200-degree field of view. UWF retinal mosaic:
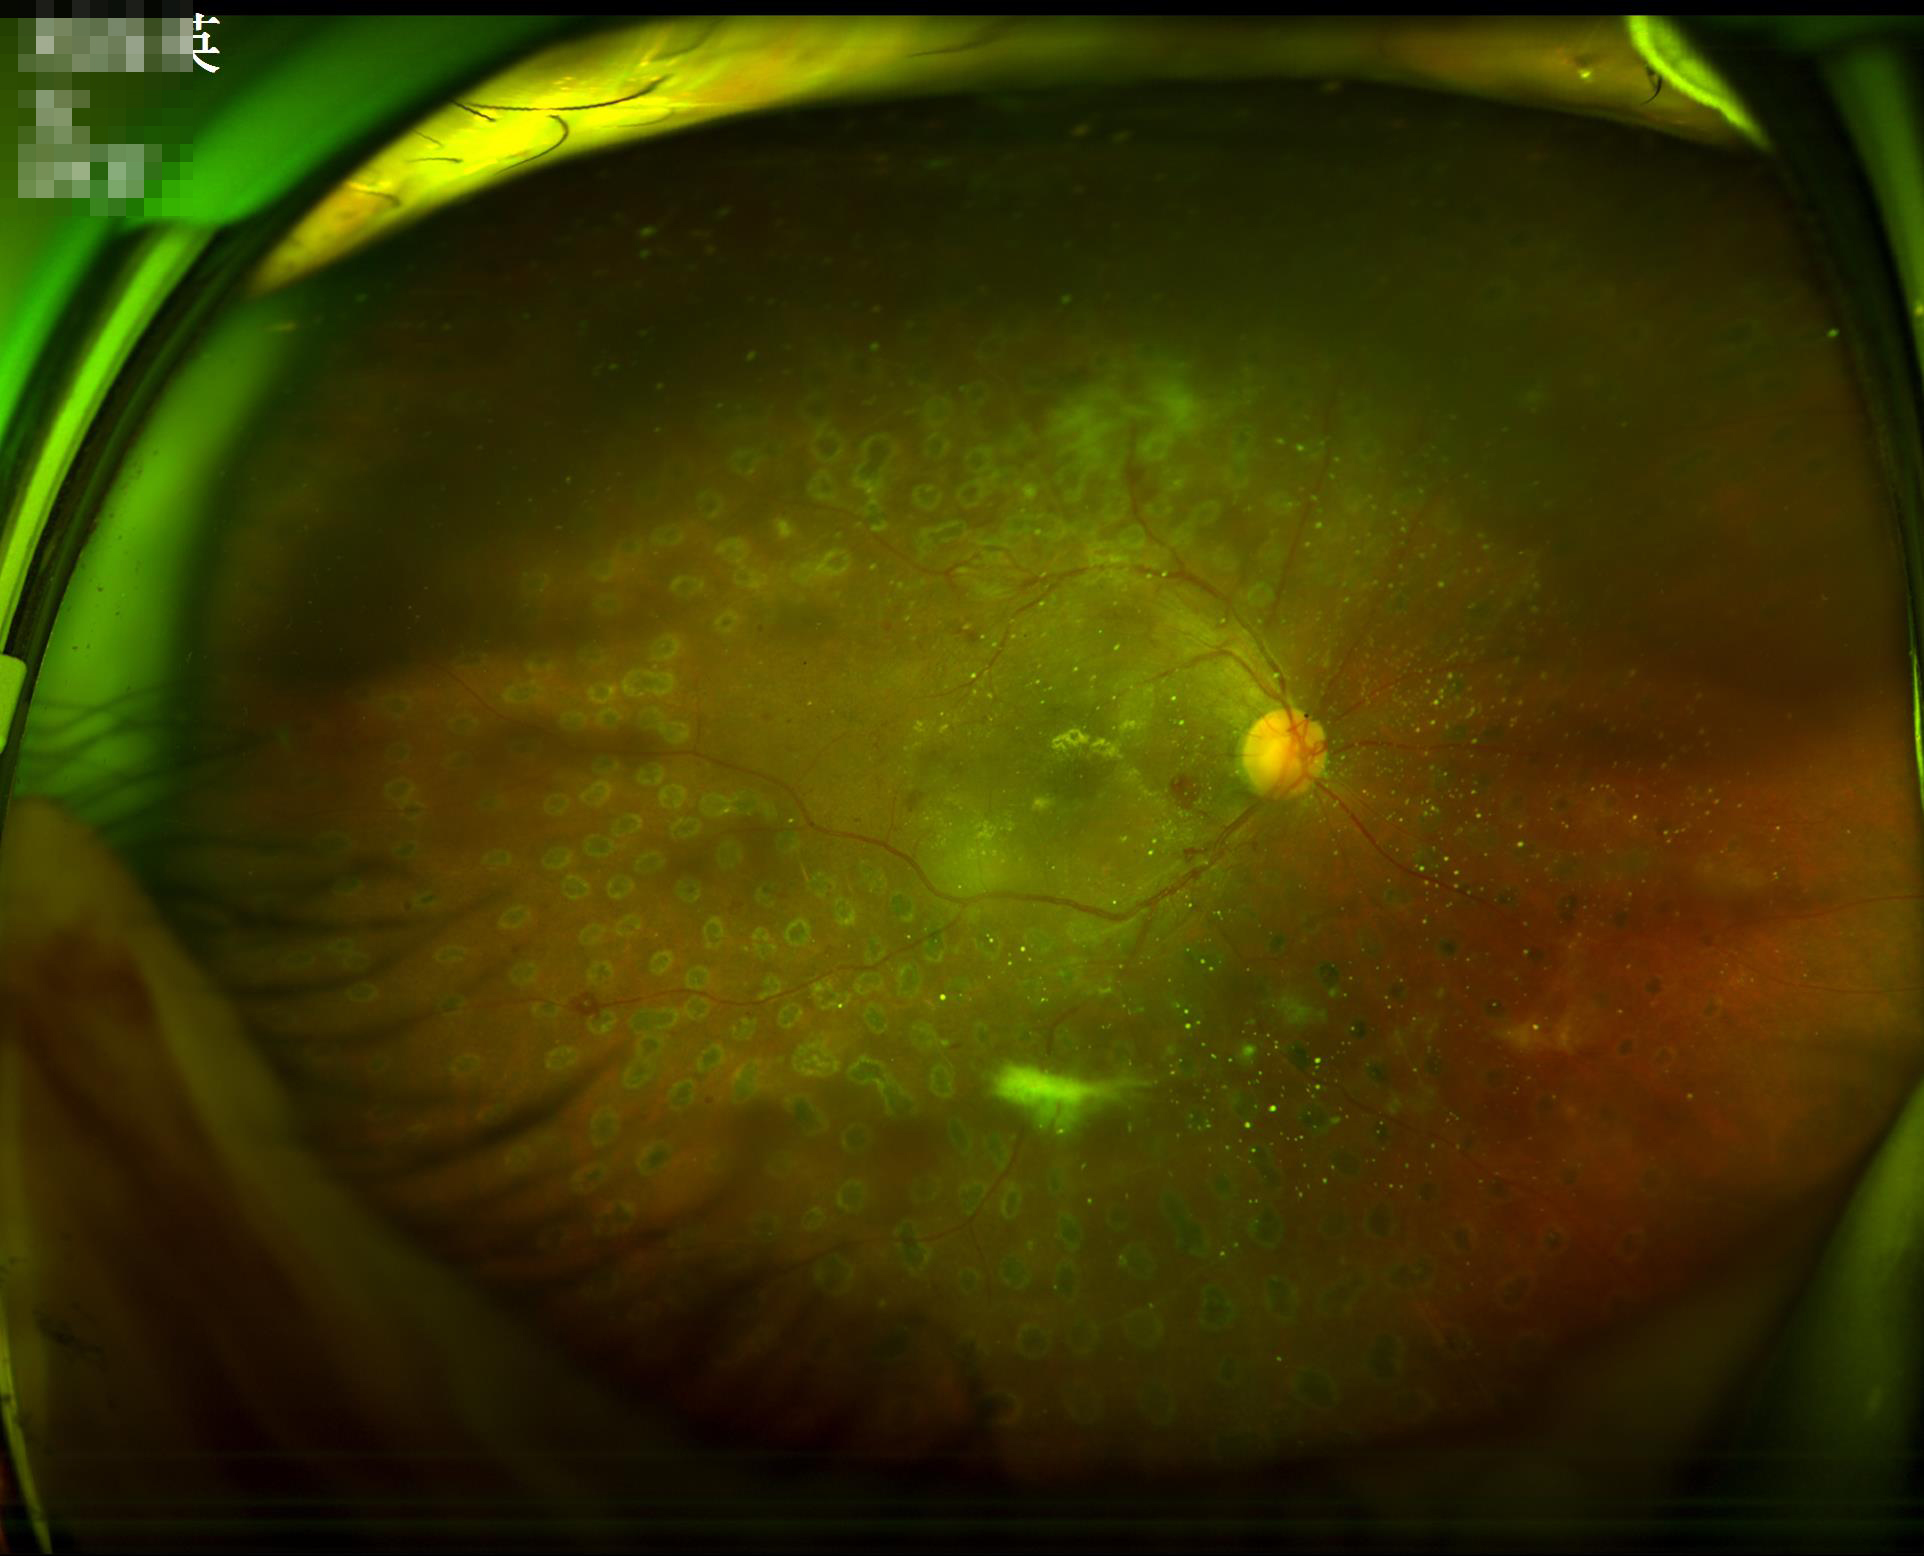

  illumination: inadequate, with uneven exposure or color distortion
  clarity: noticeable blur in the optic disc, vessels, or background
  overall_quality: poor and difficult to use diagnostically